Nonmydriatic fundus photograph, NIDEK AFC-230 fundus camera.
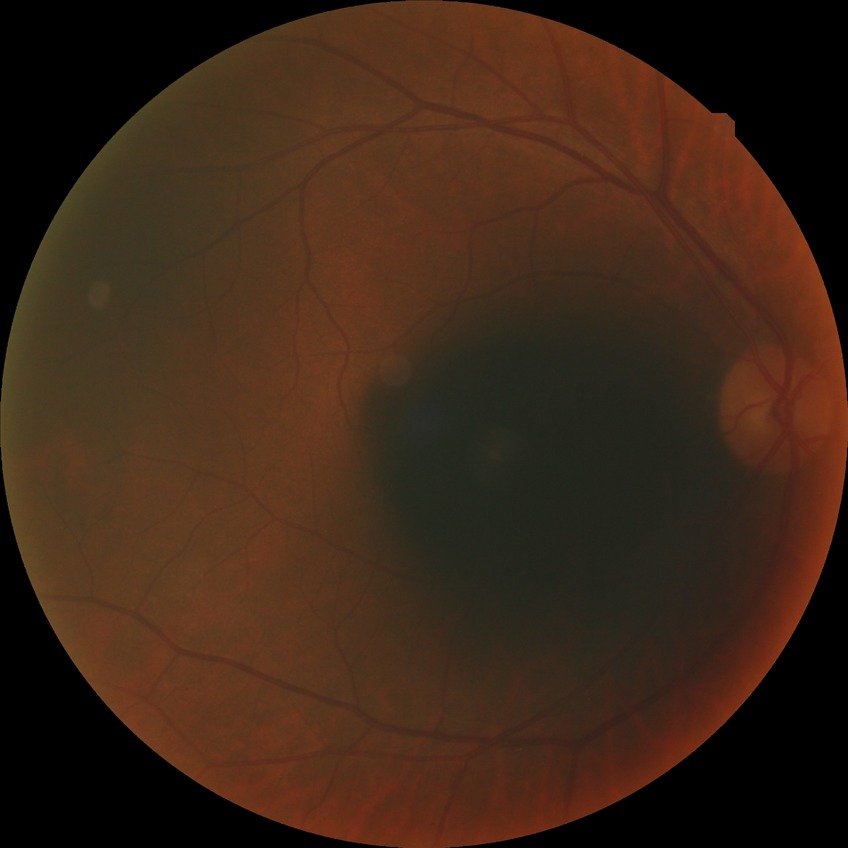

retinopathy grade = no diabetic retinopathy.